NIDEK AFC-230 fundus camera · fundus photo: 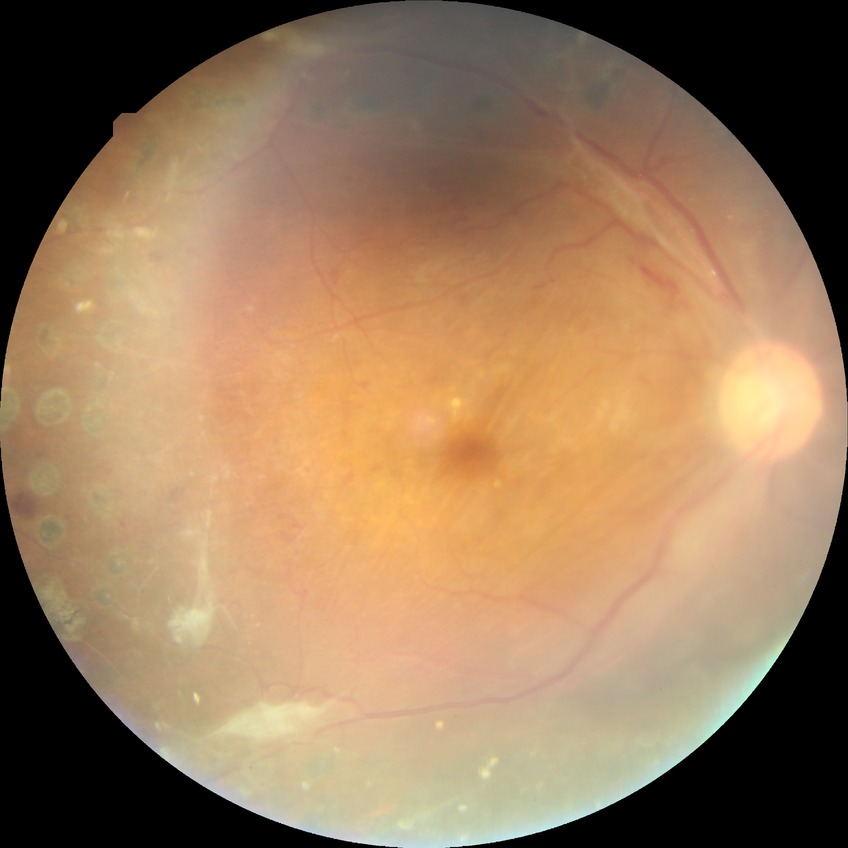

diabetic retinopathy (DR): proliferative diabetic retinopathy (PDR)